Clarity RetCam 3, 130° FOV. 640x480. Pediatric retinal photograph (wide-field): 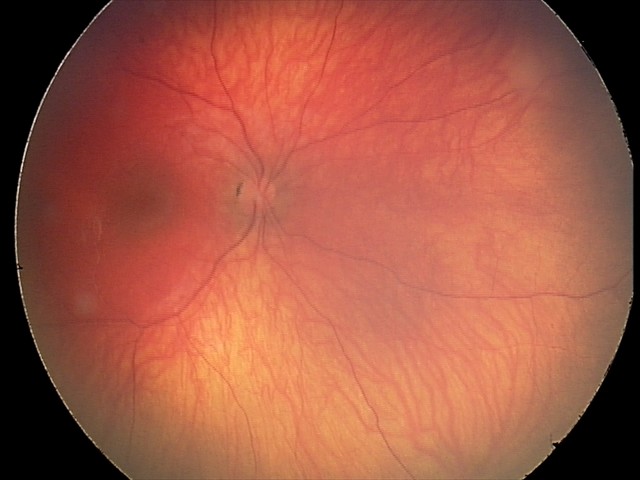 Screening examination consistent with retinal astrocytic hamartoma.